Retinal fundus photograph, 848x848px, nonmydriatic, acquired with a NIDEK AFC-230:
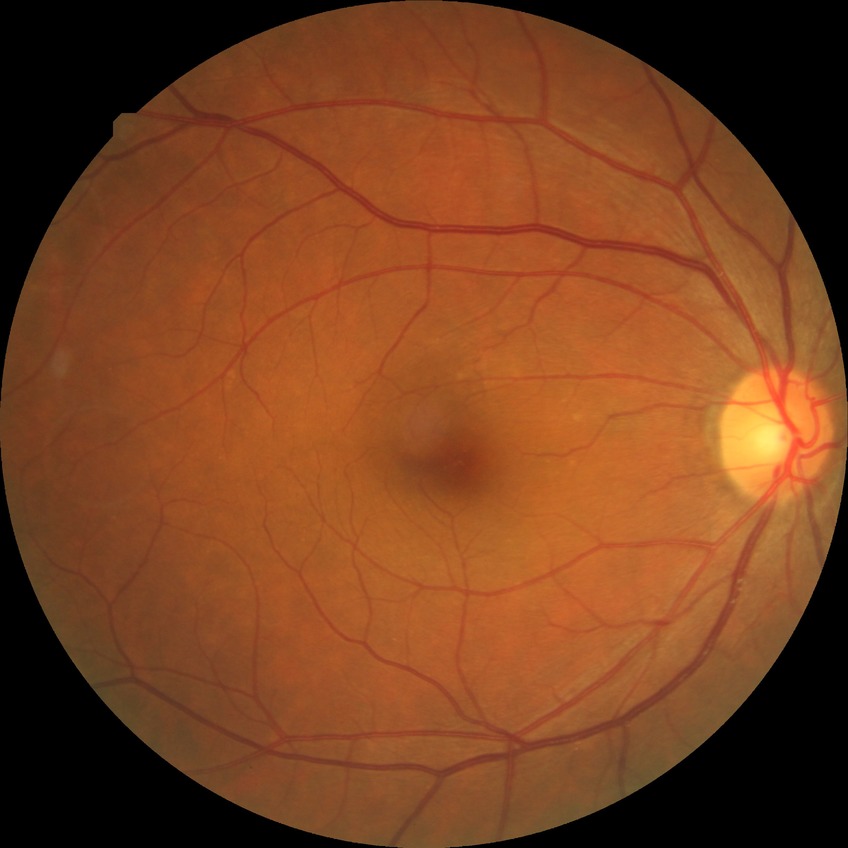
Diabetic retinopathy grade is no diabetic retinopathy.